CFP, 2346x1568: 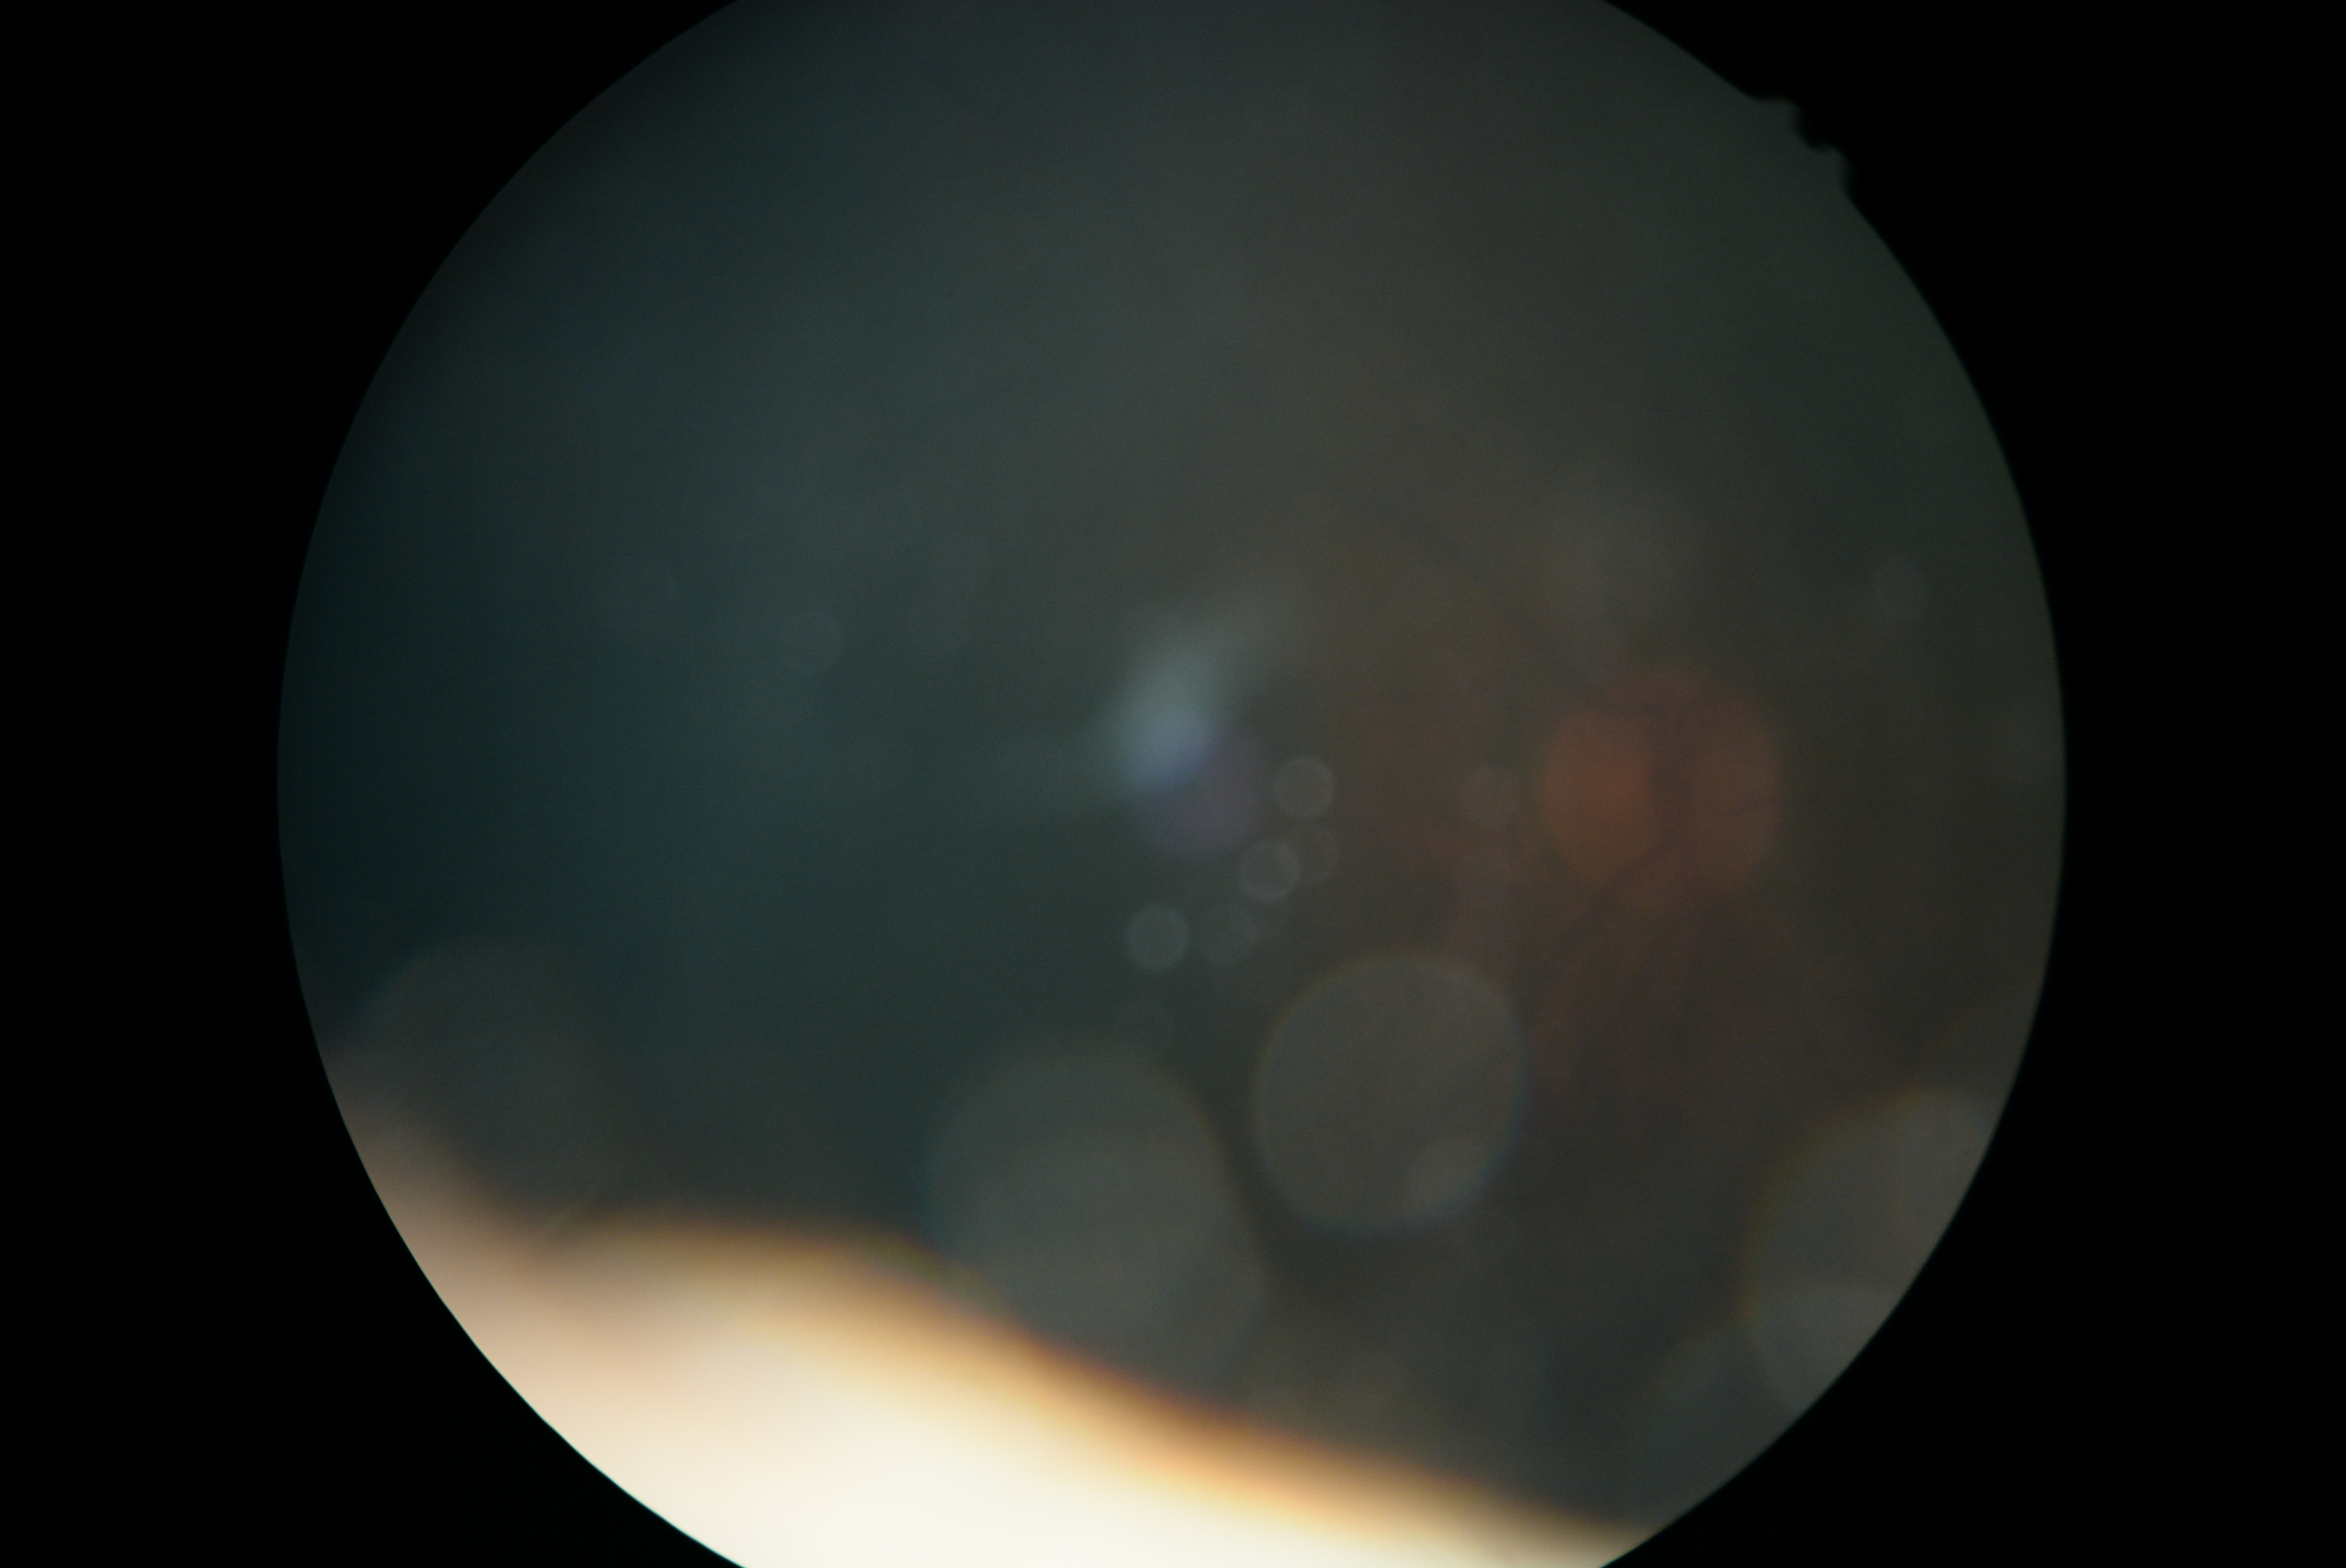

DR grade=ungradable due to poor image quality.